Captured with the Phoenix ICON (100° field of view) · 1240 by 1240 pixels · pediatric wide-field fundus photograph
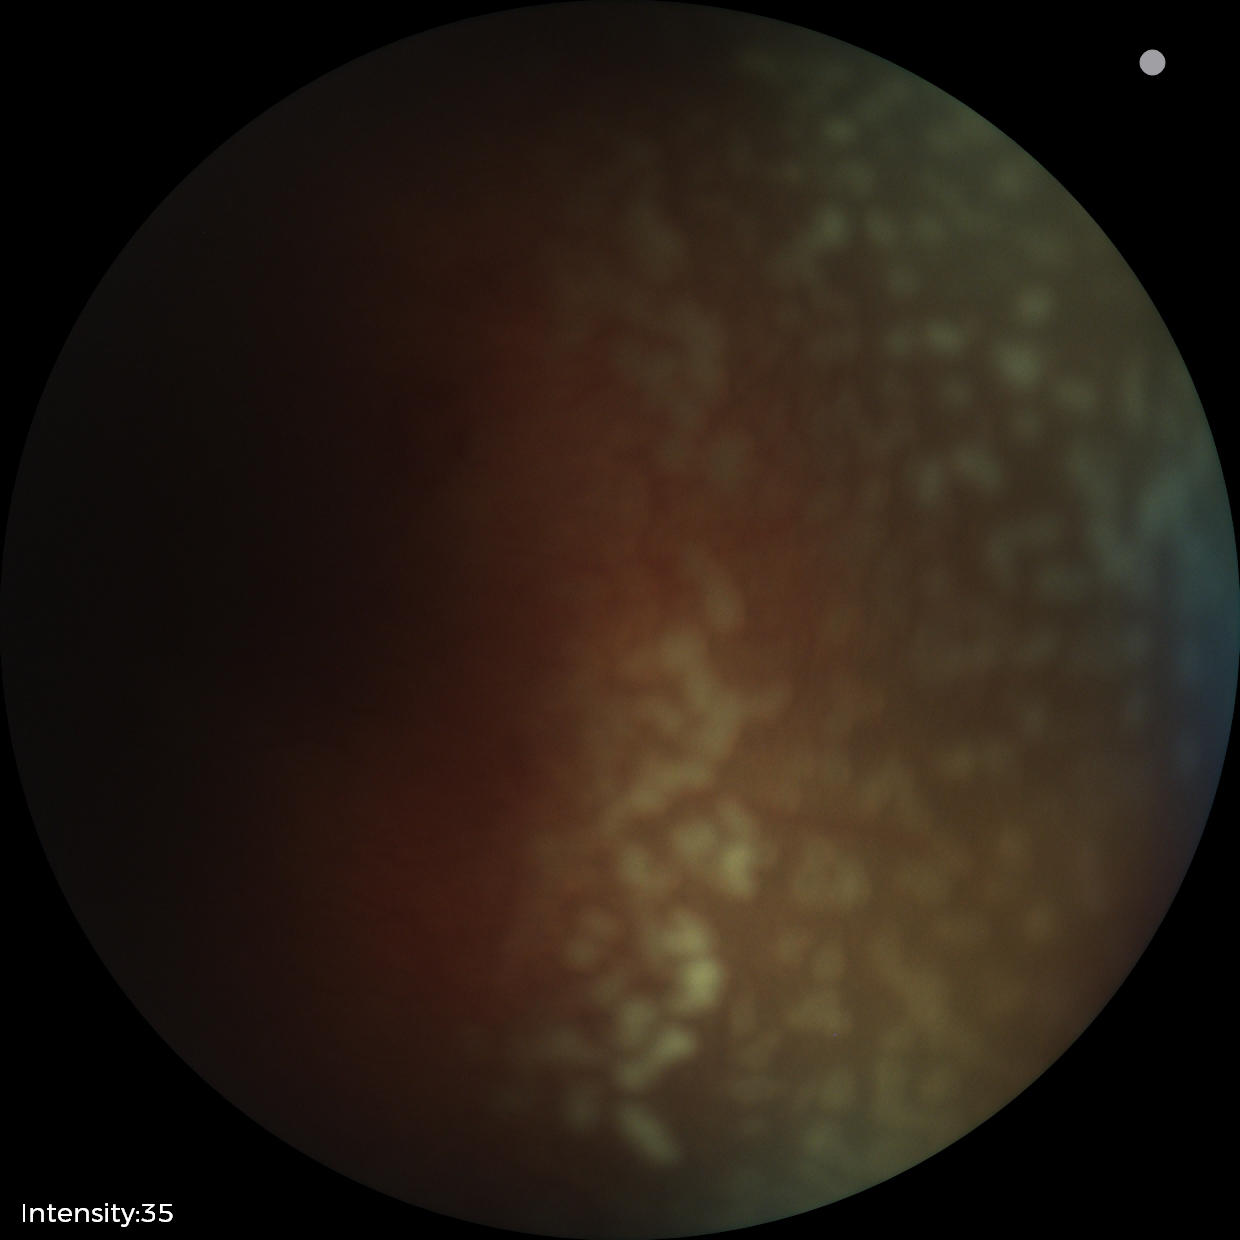

Q: What is the diagnosis from this examination?
A: ROP stage 2
Q: What is the plus-form classification?
A: plus disease